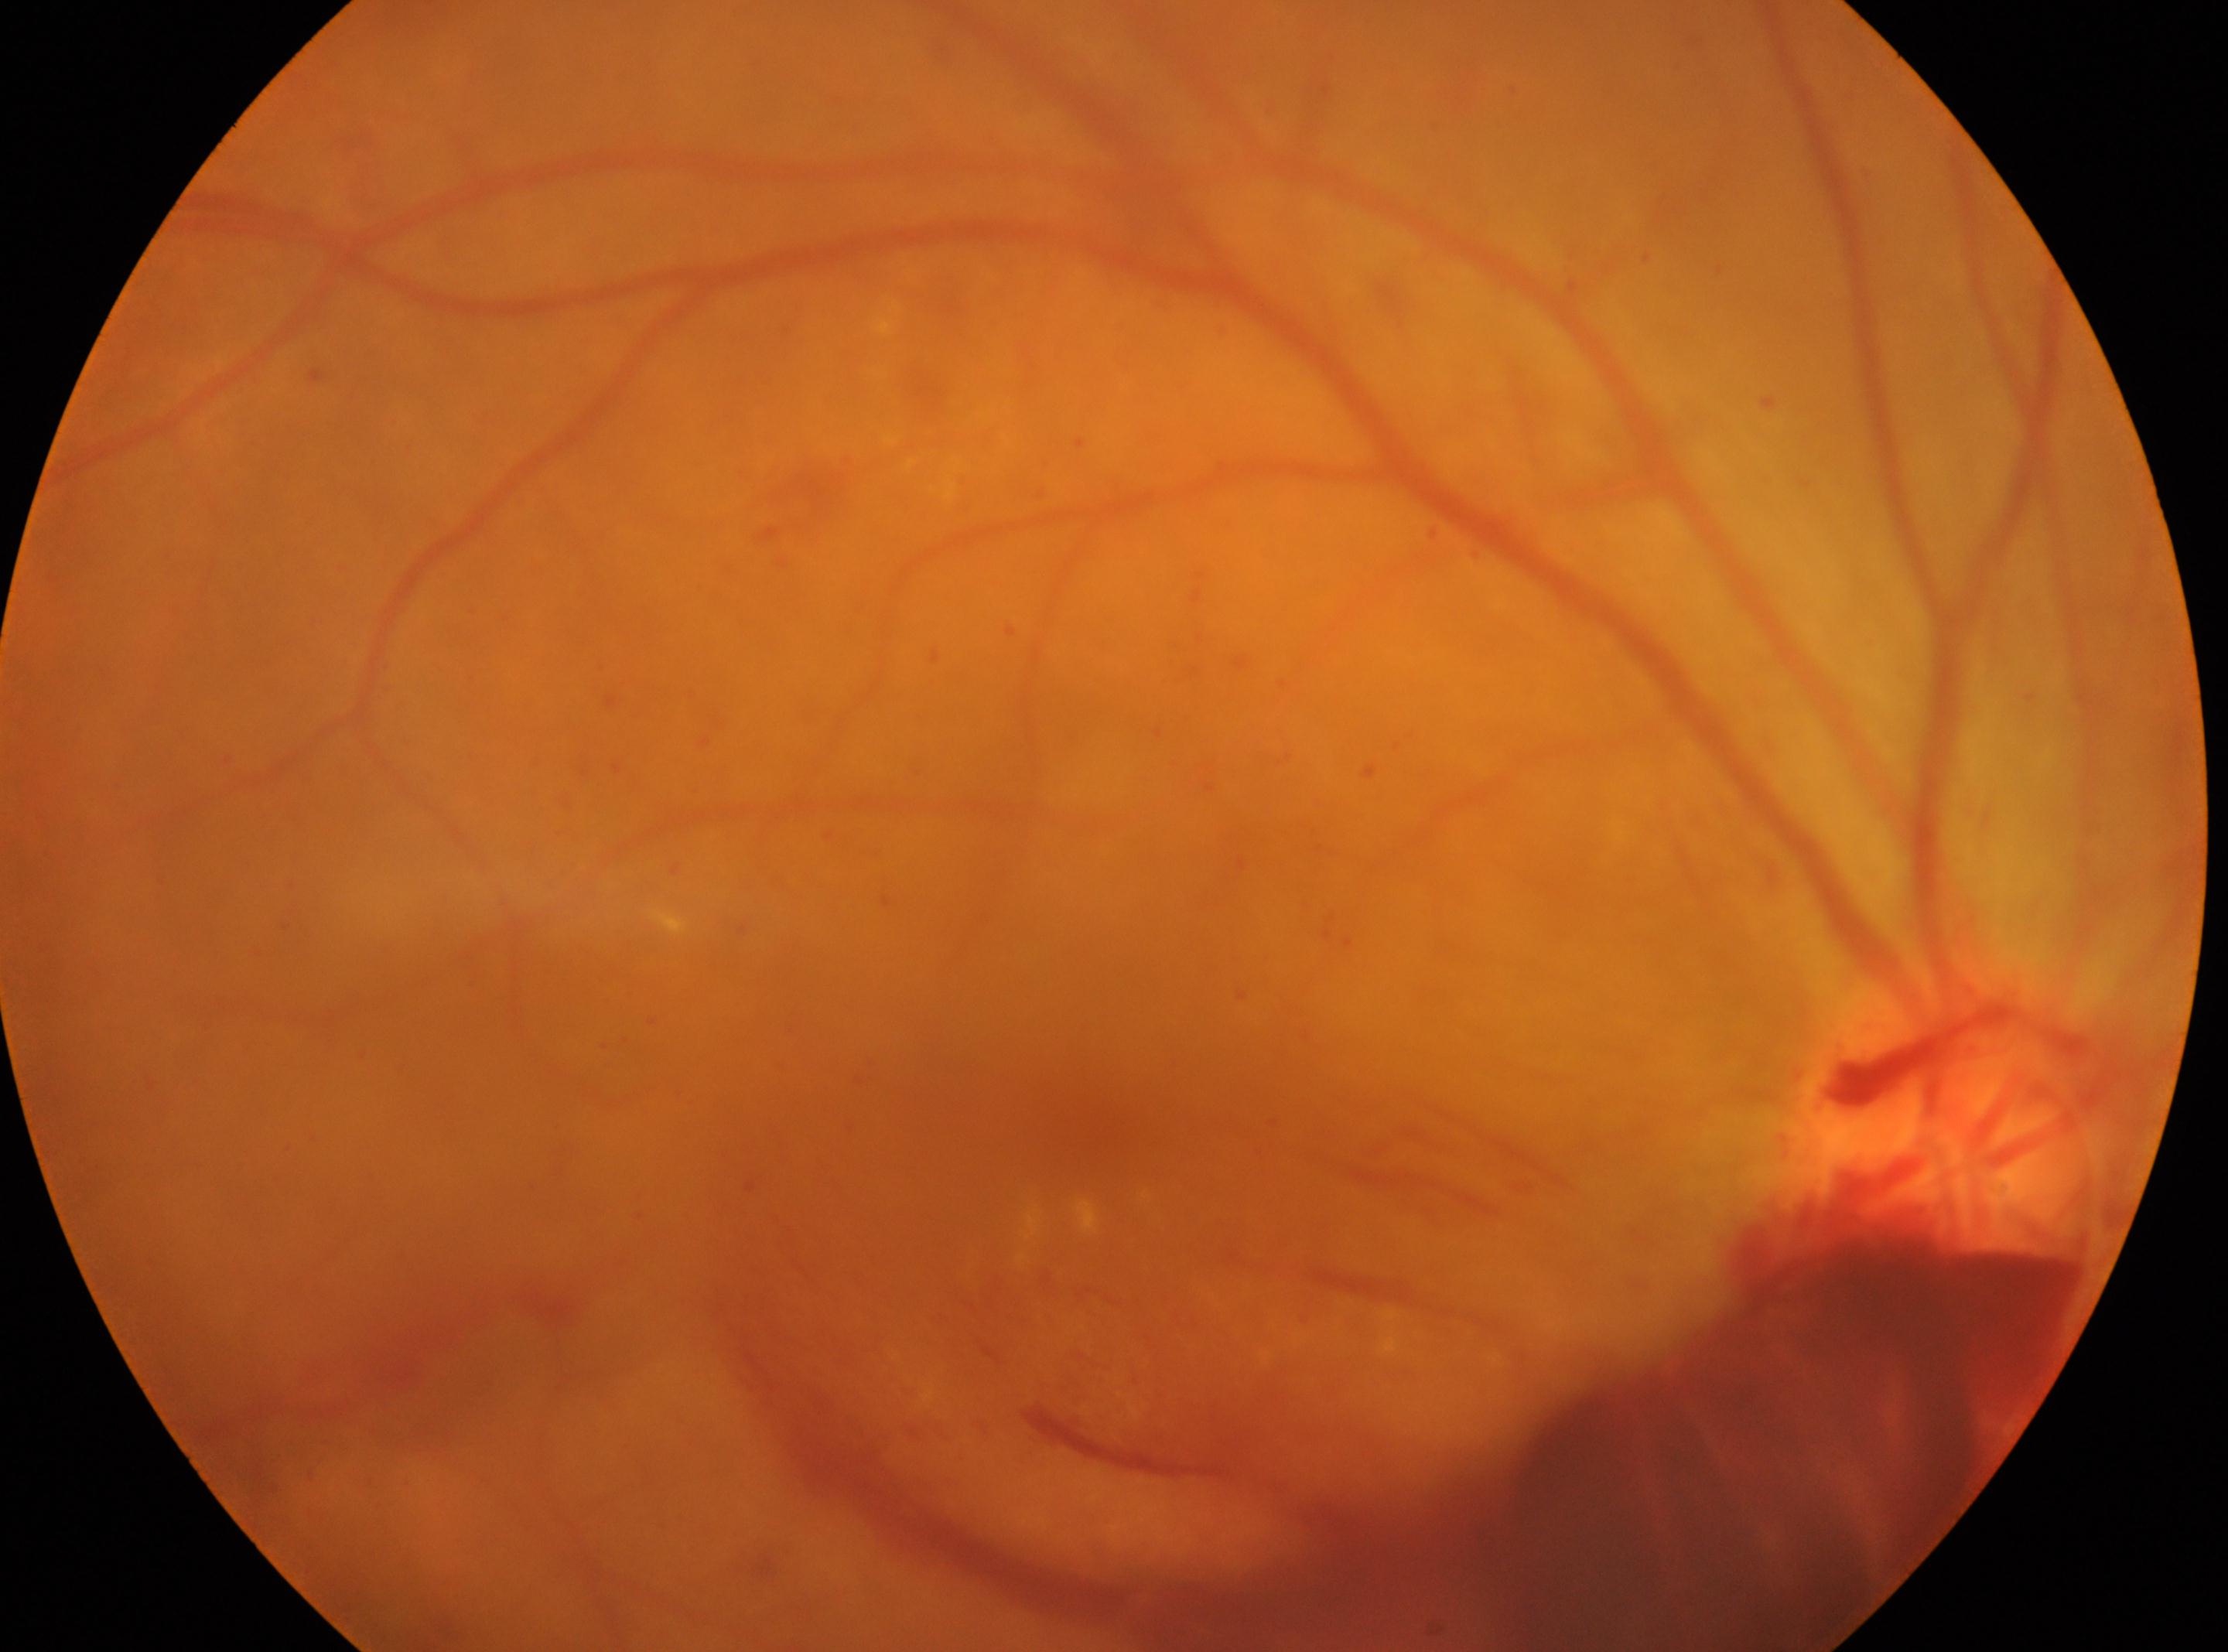
Optic disc center located at [1953, 1129].
DR grade is 4 — neovascularization and/or vitreous/pre-retinal hemorrhage.
The macular center is at [1077, 1118].
This is the OD.